2048 by 1536 pixels.
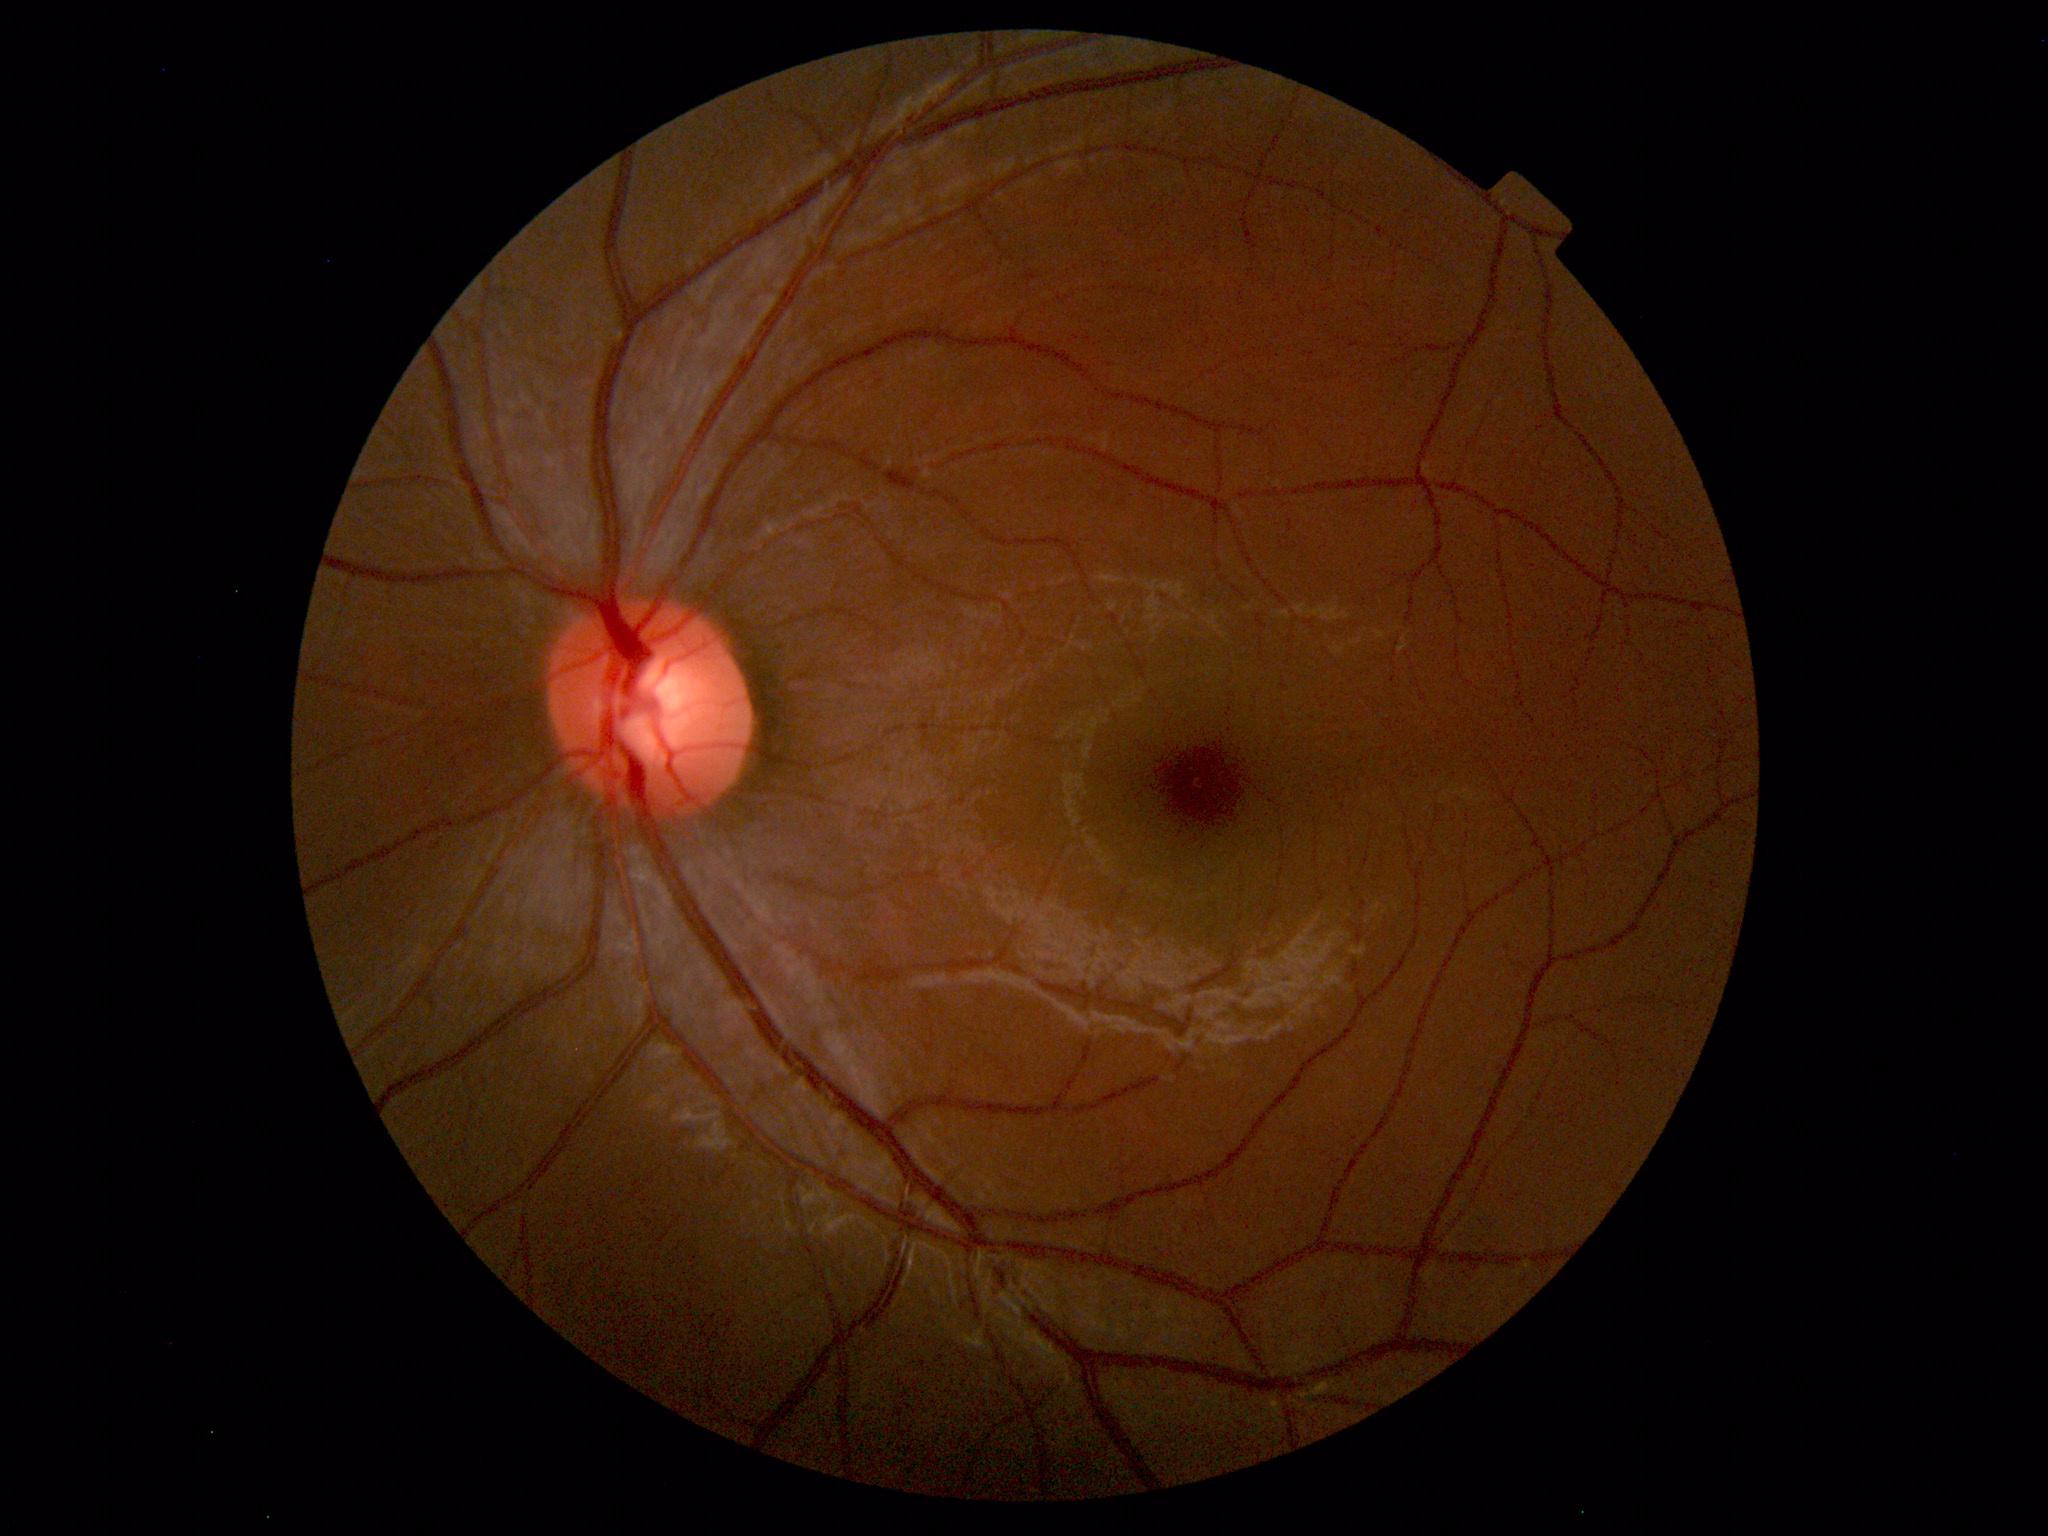 No retinal pathology identified.